DR severity per modified Davis staging:
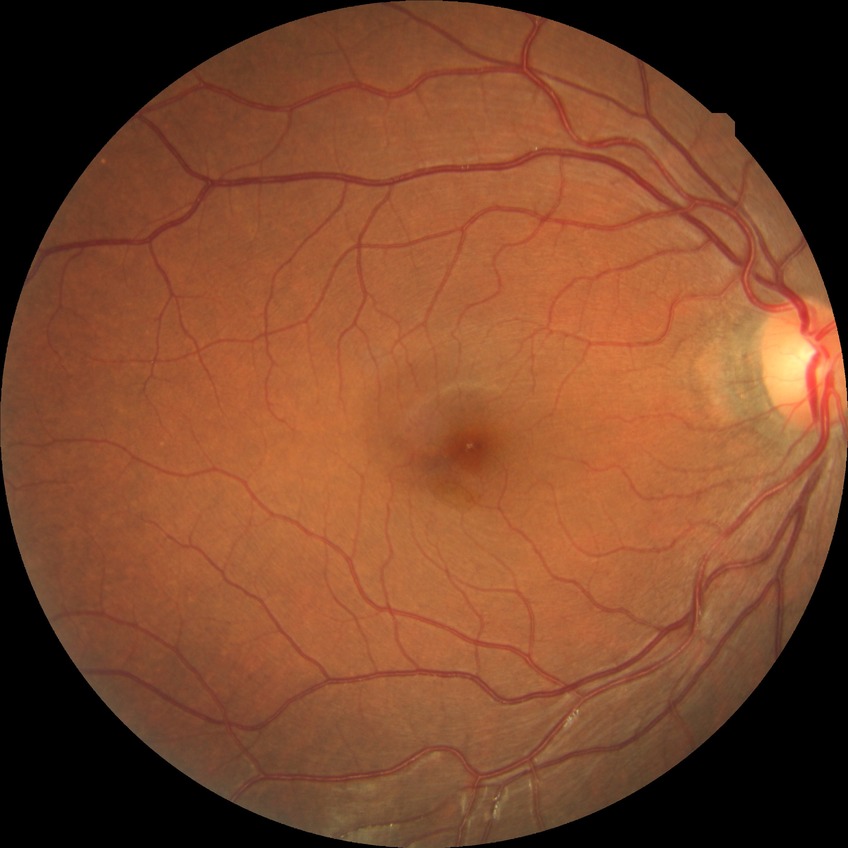 Assessment:
- retinopathy stage — no diabetic retinopathy